Wide-field fundus photograph from neonatal ROP screening: 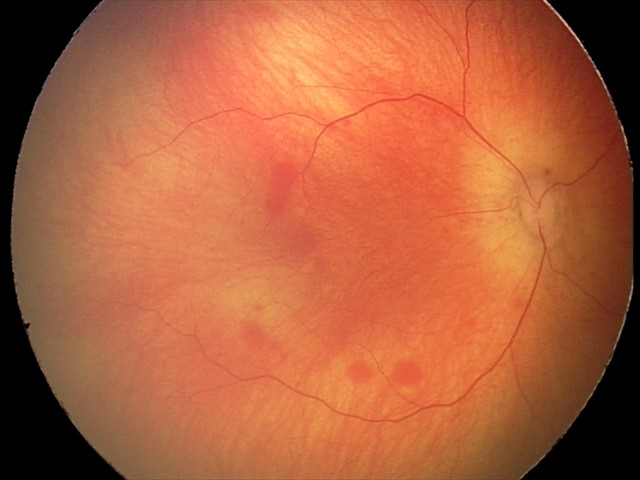

Impression: retinal hemorrhages.